45-degree field of view
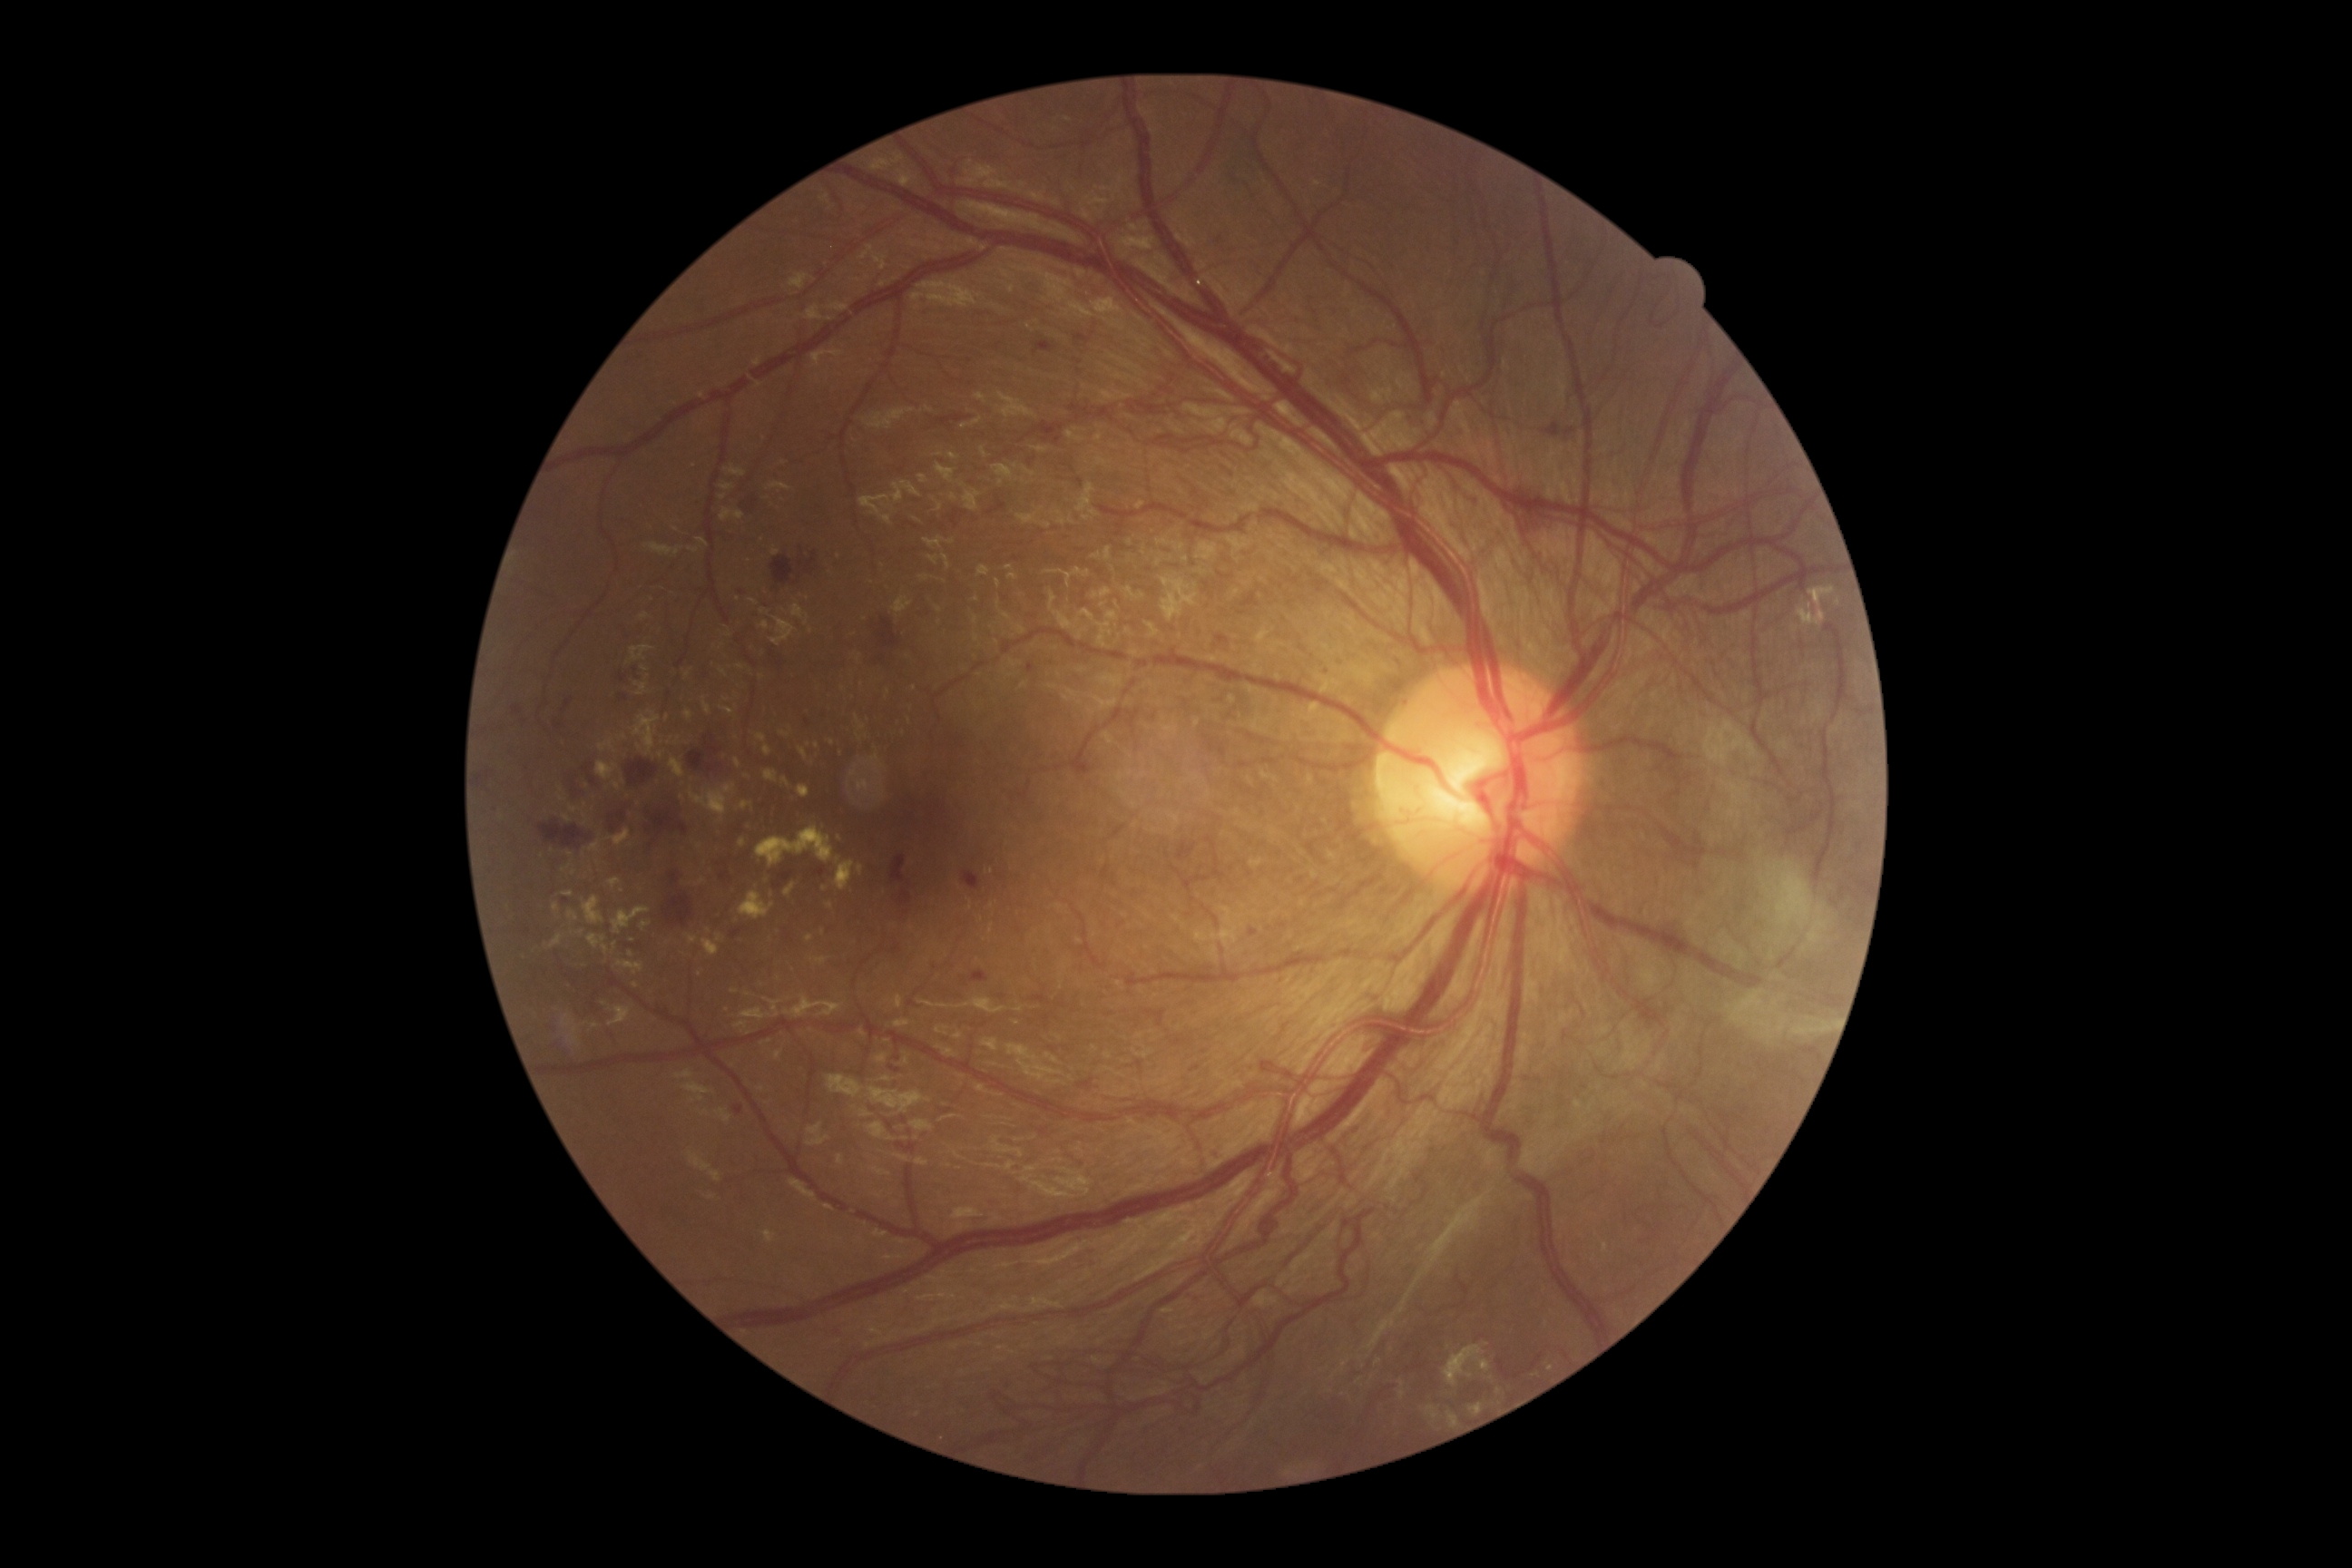 partial: true
dr_grade: 4
dr_grade_name: PDR
lesions:
  he:
    - [747, 495, 767, 520]
    - [734, 1106, 745, 1115]
    - [1128, 710, 1141, 734]
    - [556, 723, 564, 730]
    - [772, 556, 794, 585]
    - [1034, 340, 1057, 357]
    - [564, 700, 573, 712]
    - [652, 808, 689, 838]
    - [818, 707, 830, 721]
    - [1344, 377, 1351, 387]
    - [1079, 1079, 1093, 1090]
    - [669, 872, 680, 885]
    - [625, 760, 658, 787]
    - [972, 970, 990, 983]
  he_small:
    - (1219; 240)
    - (567; 901)
    - (1003; 997)
  ex:
    - [763, 747, 772, 756]
    - [600, 740, 614, 752]
    - [691, 785, 734, 823]
    - [569, 910, 580, 921]
    - [812, 957, 828, 966]
    - [564, 892, 574, 897]
    - [553, 903, 560, 912]
    - [756, 734, 767, 743]
    - [582, 896, 605, 925]
    - [609, 830, 631, 847]
  ex_small:
    - (571; 856)
    - (574; 874)
    - (632; 941)
    - (844; 689)
    - (623; 737)
    - (832; 743)
    - (615; 945)
    - (729; 636)